Color fundus image:
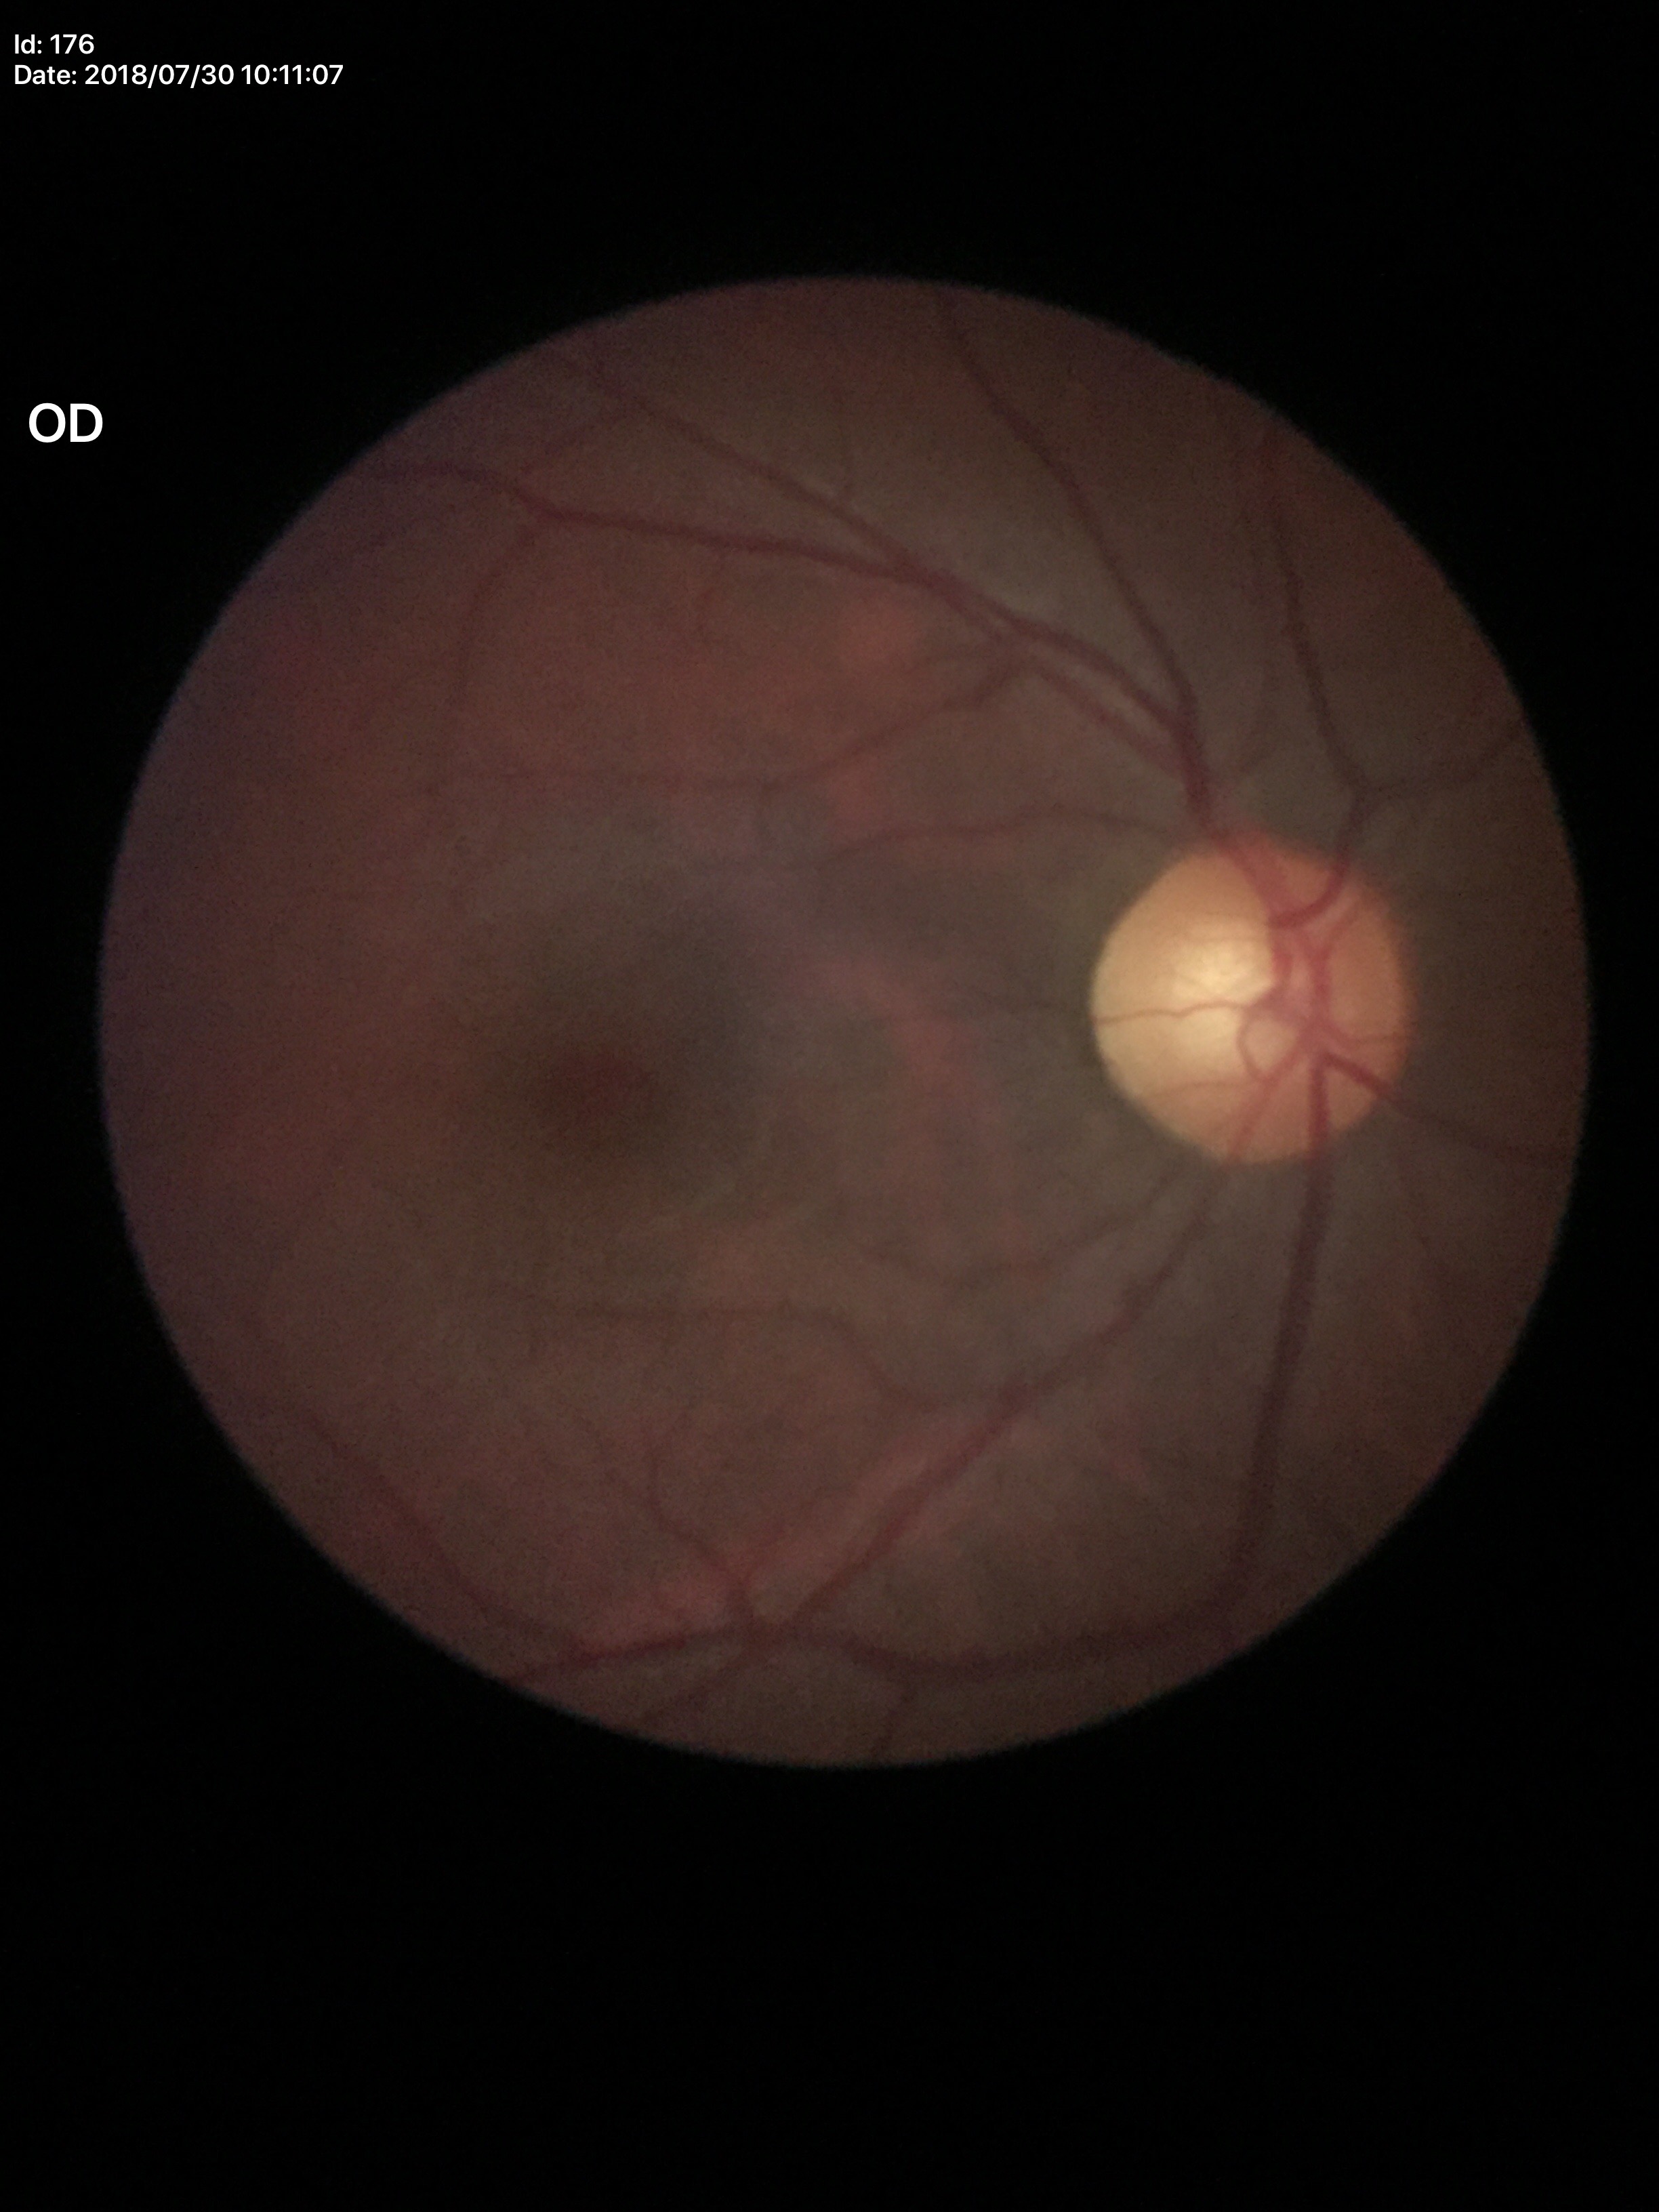 Glaucoma screening = not suspect; VCDR = 0.57; HCDR = 0.57.